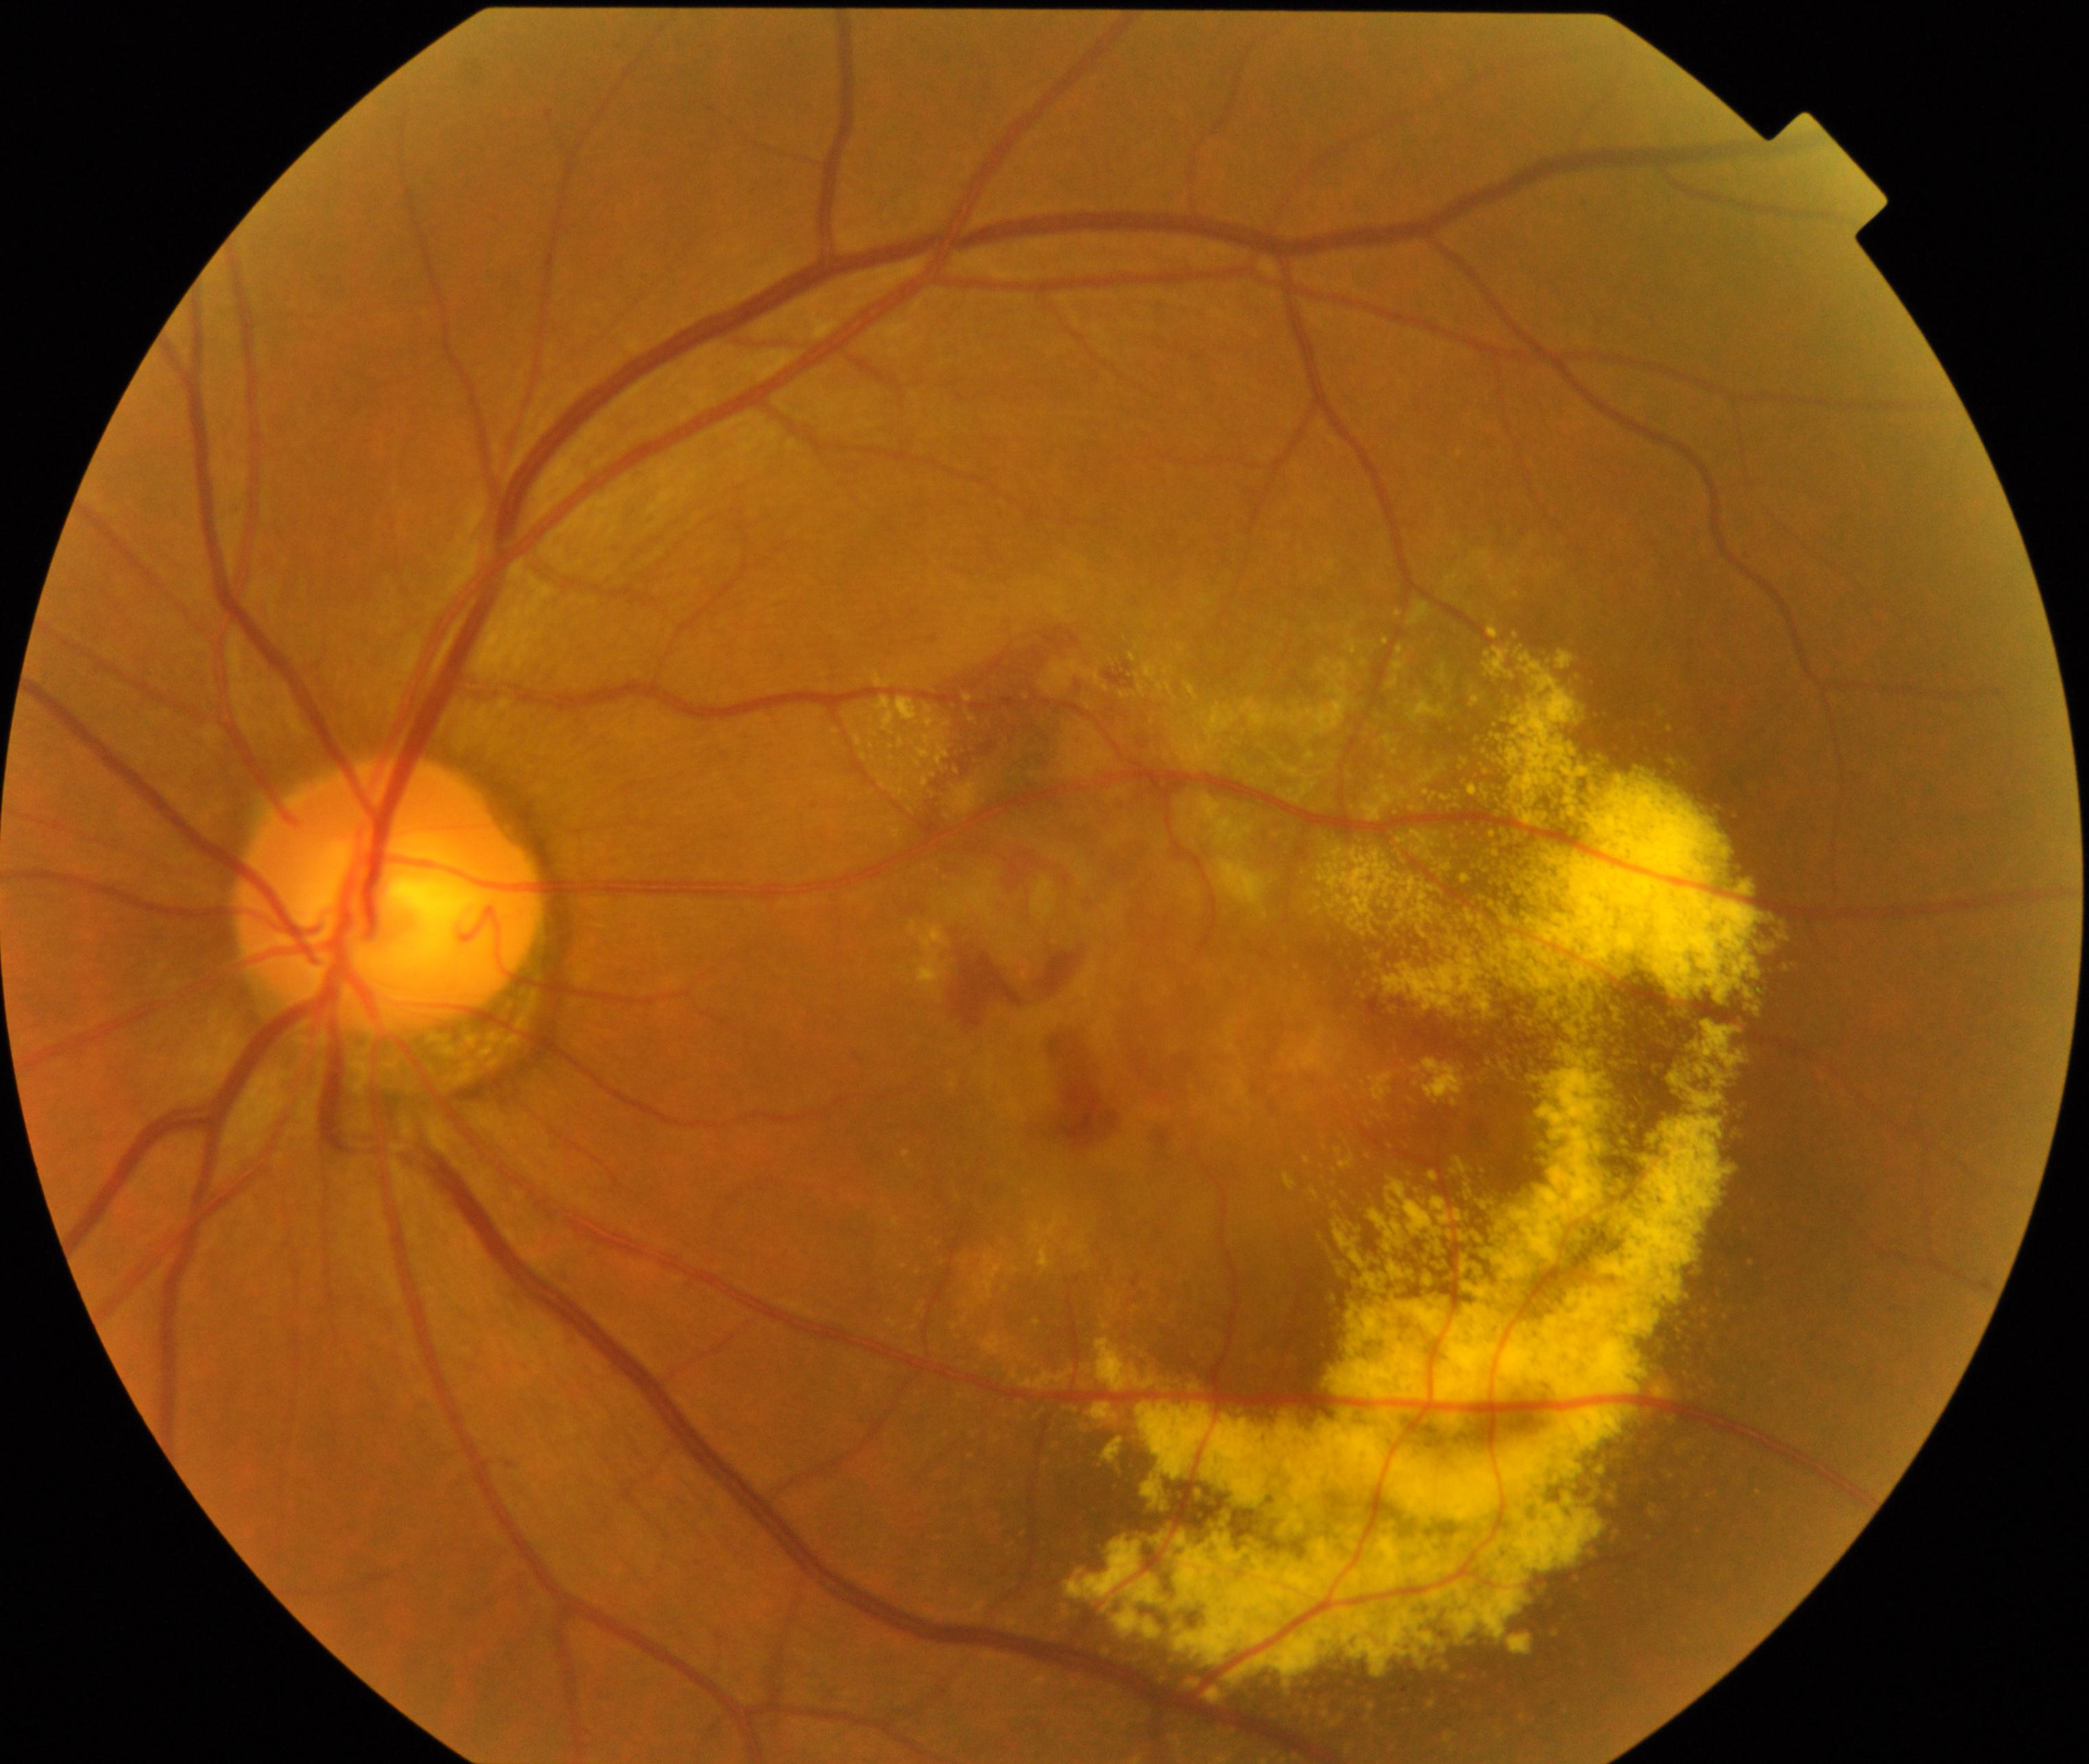 Impression: maculopathy.